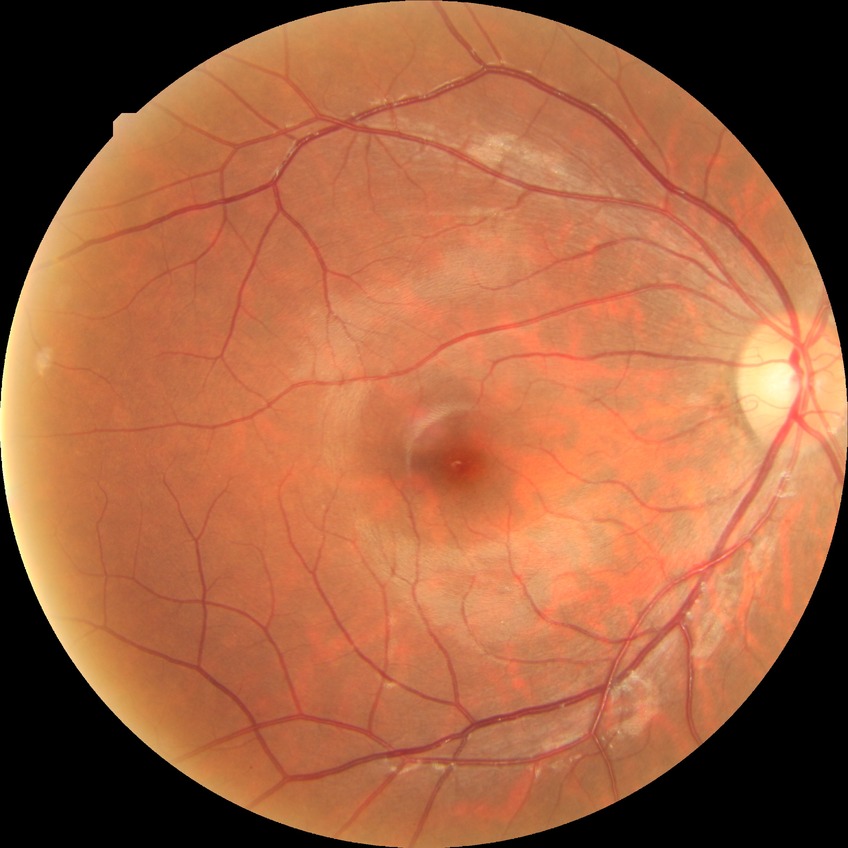
Retinopathy grade is no diabetic retinopathy.